Camera: Remidio Fundus on Phone.
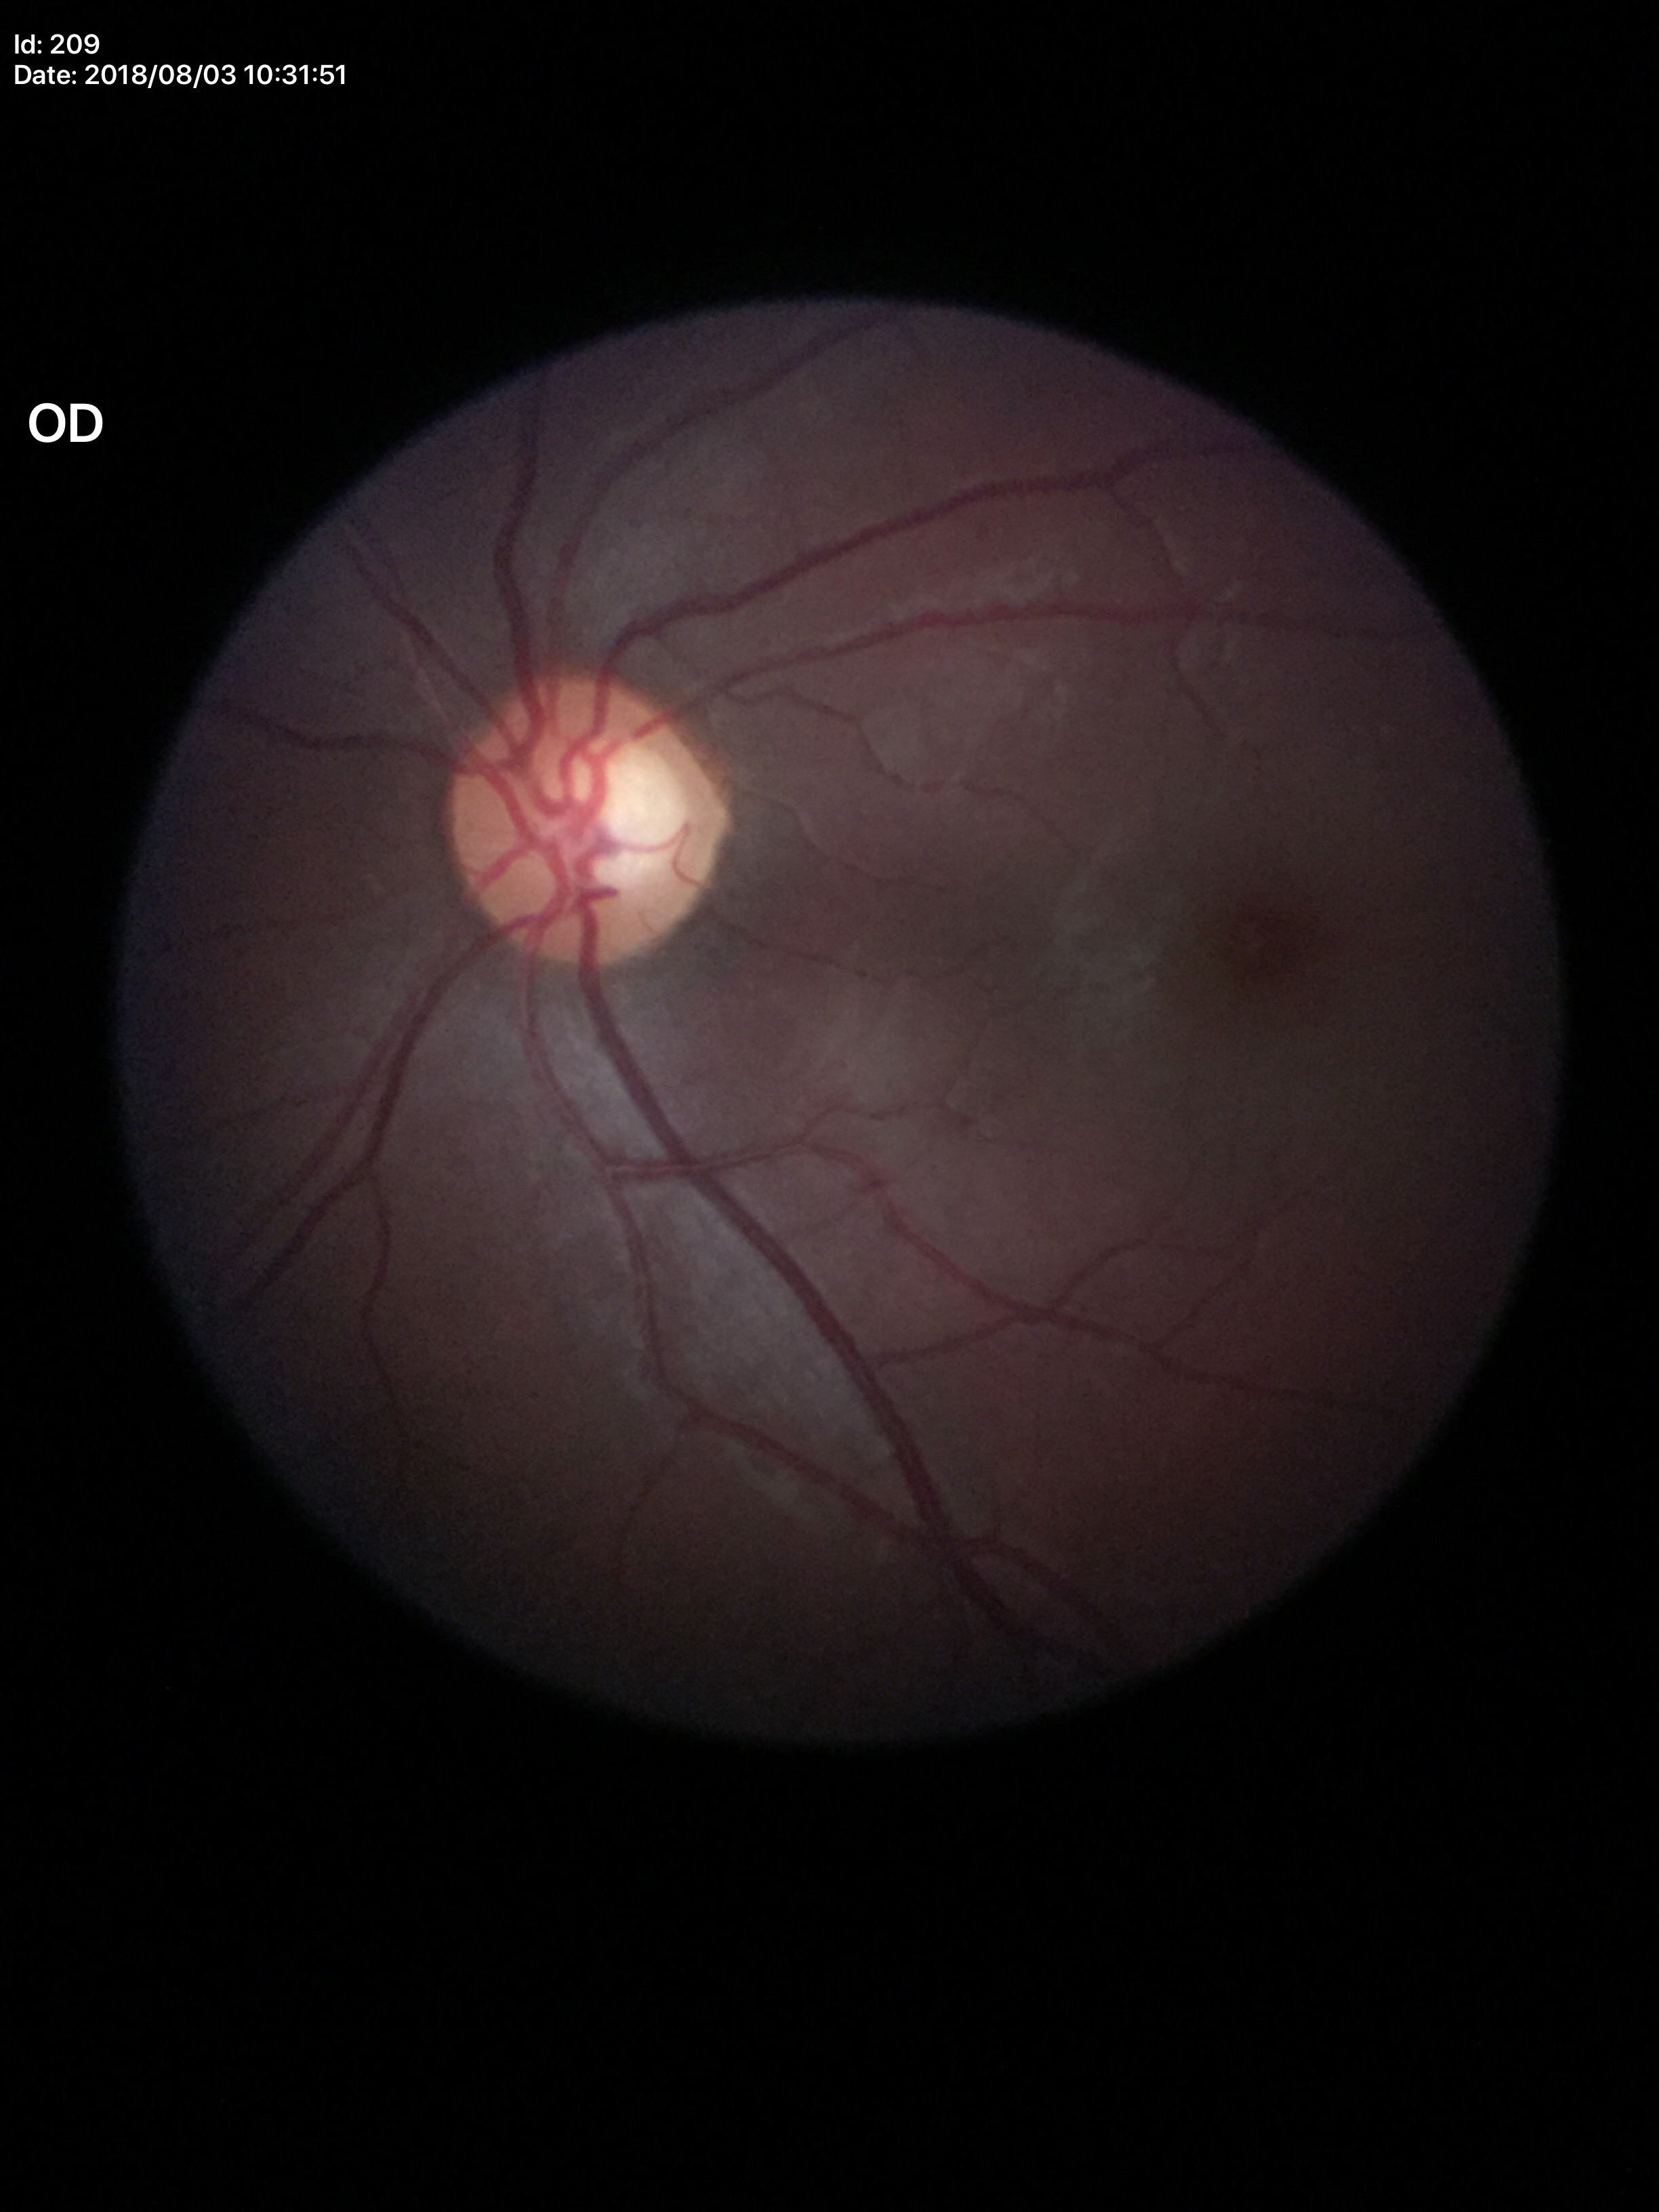
Negative for glaucoma suspicion. Vertical C/D ratio (VCDR) of 0.60. Area C/D ratio (ACDR) of 0.33.